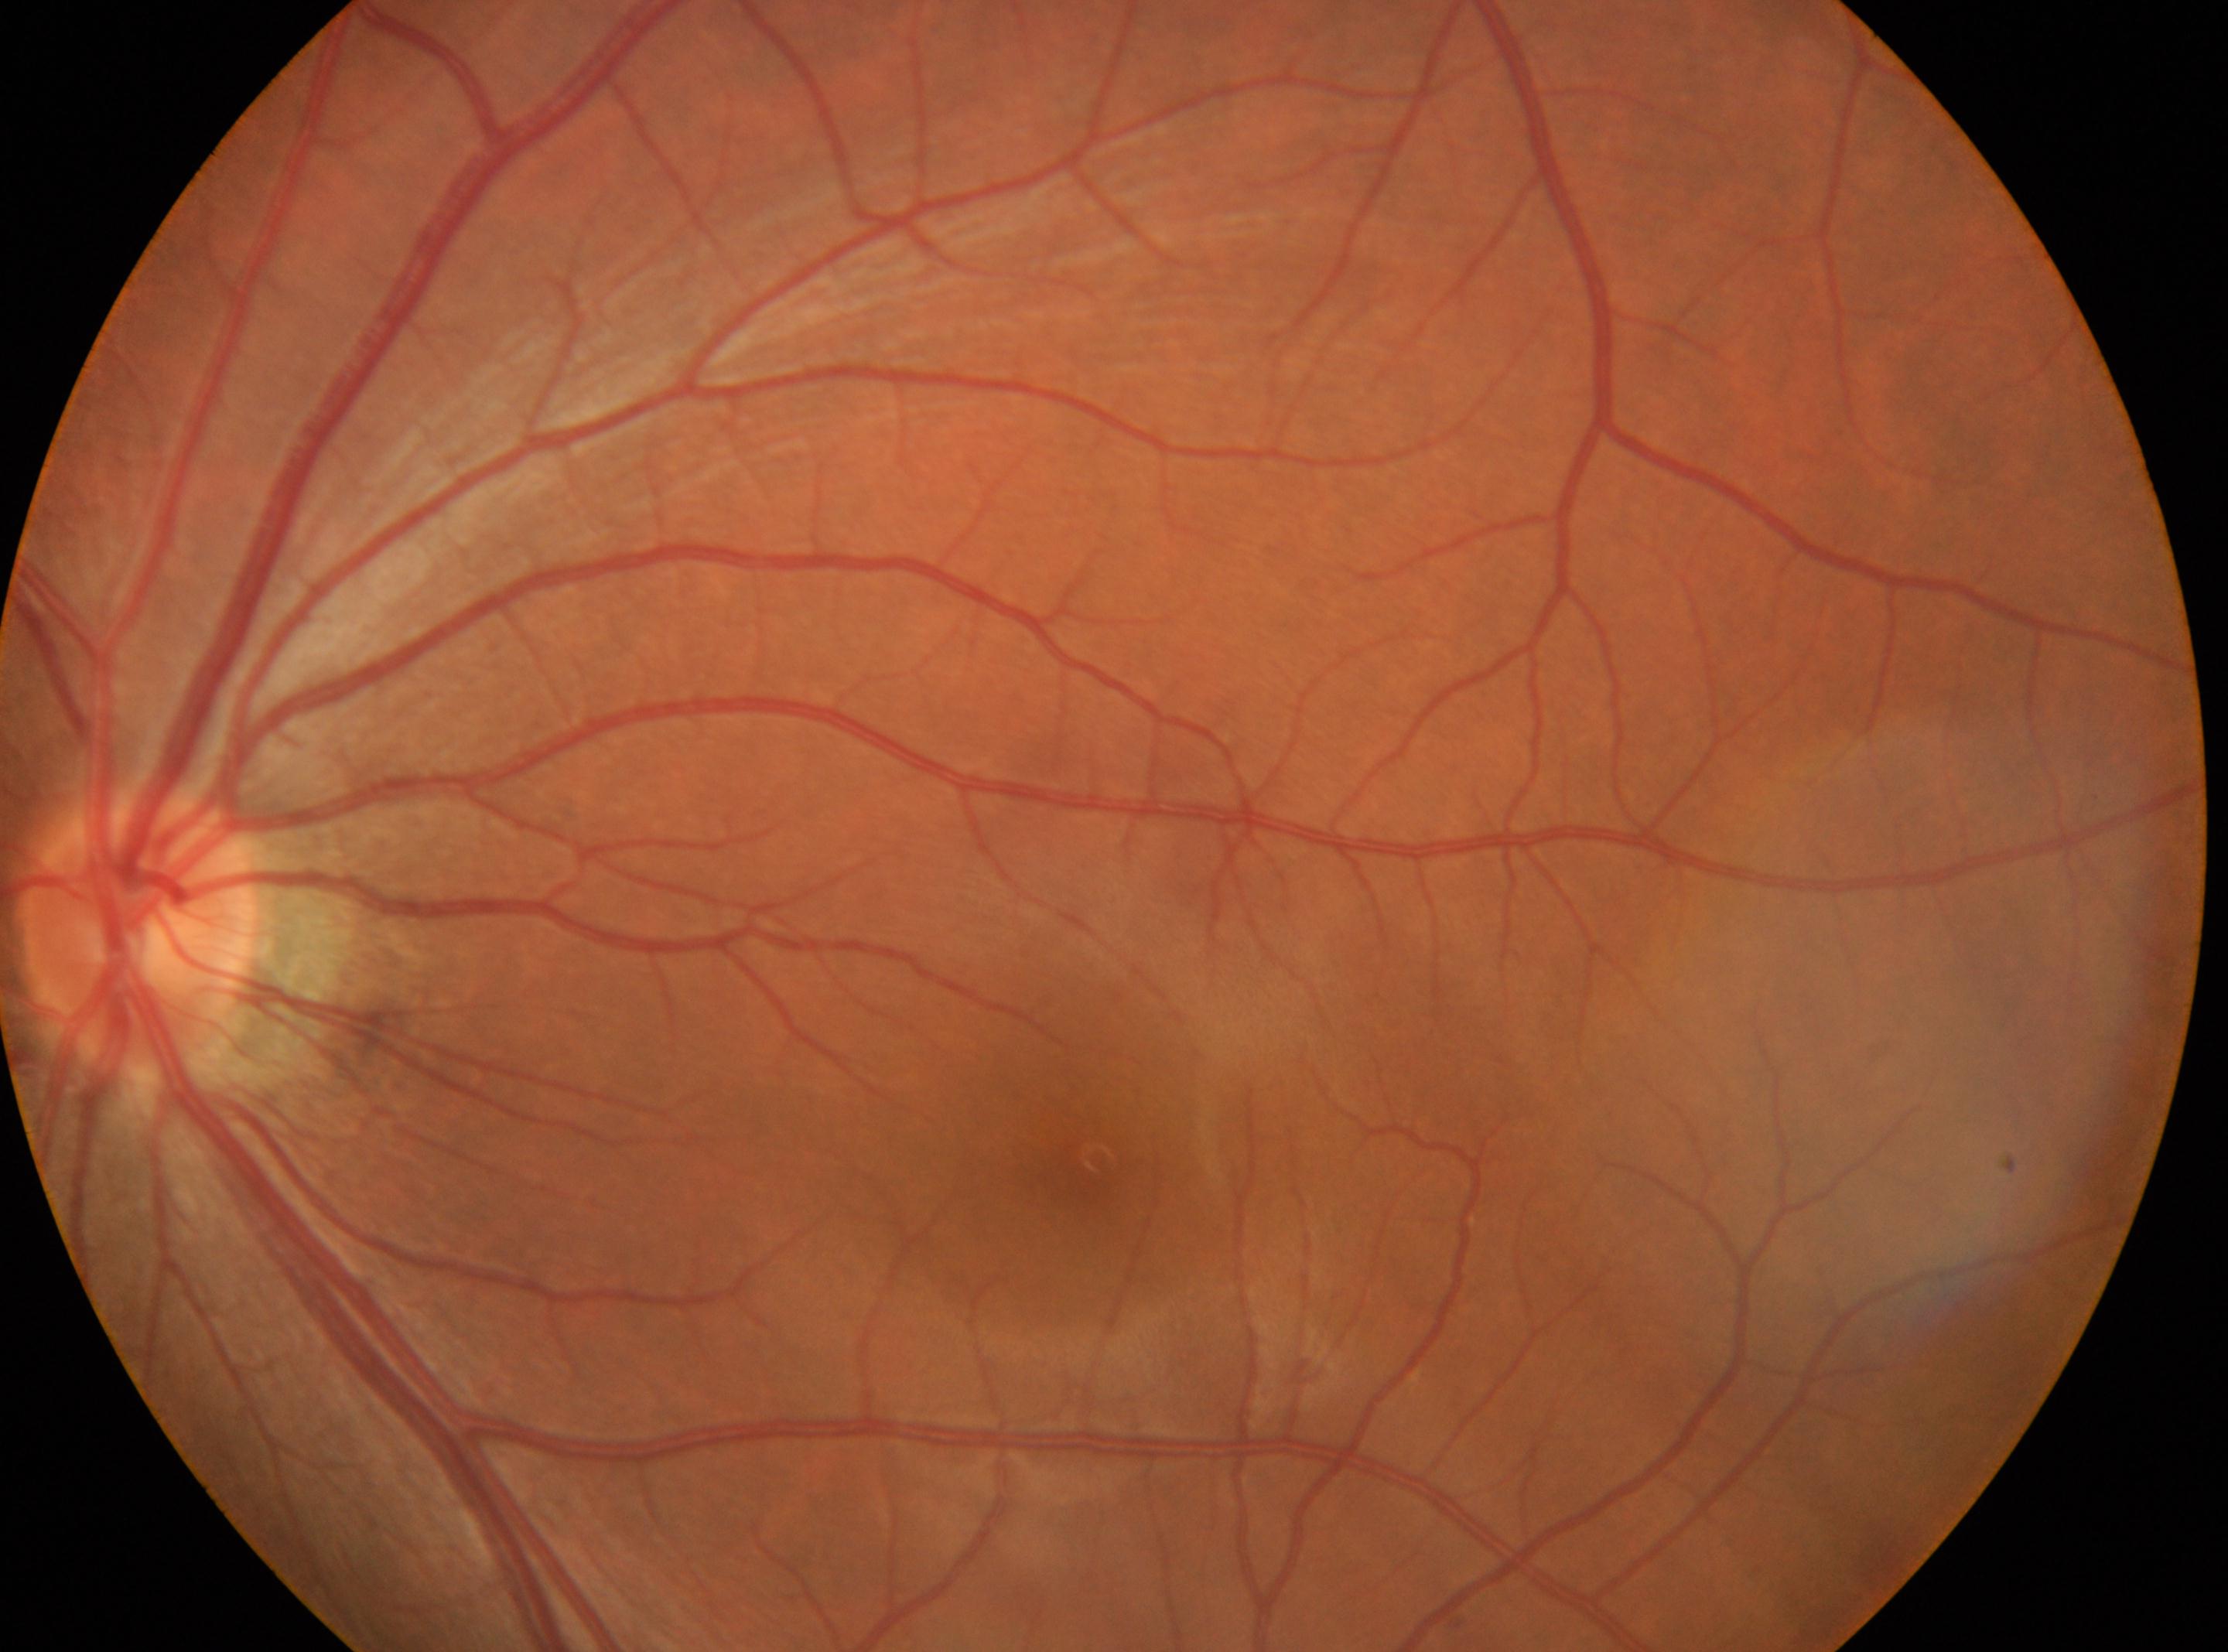
Annotations:
• laterality · the left eye
• optic disk · x=138, y=930
• diabetic retinopathy · grade 0 (no apparent retinopathy)
• fovea centralis · x=1082, y=1163